Retinal fundus photograph, nonmydriatic fundus photograph — 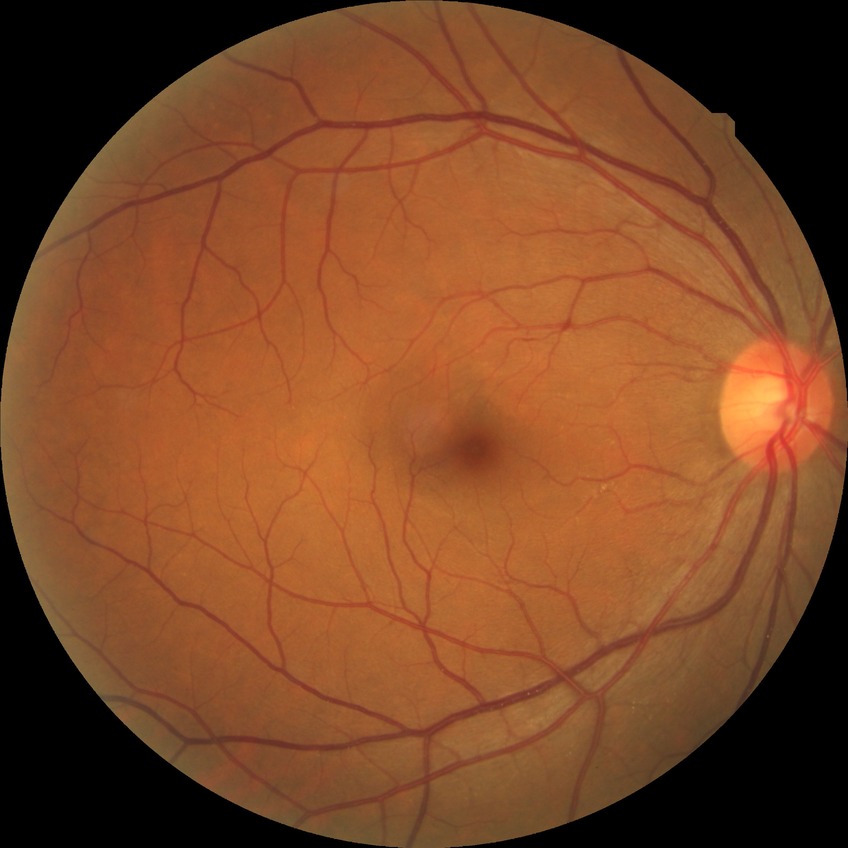 modified Davis classification = no diabetic retinopathy.